Wide-field contact fundus photograph of an infant
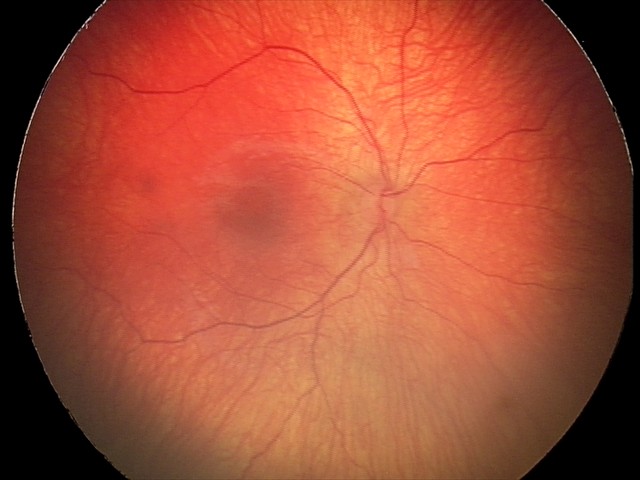

Screening series with status post ROP.